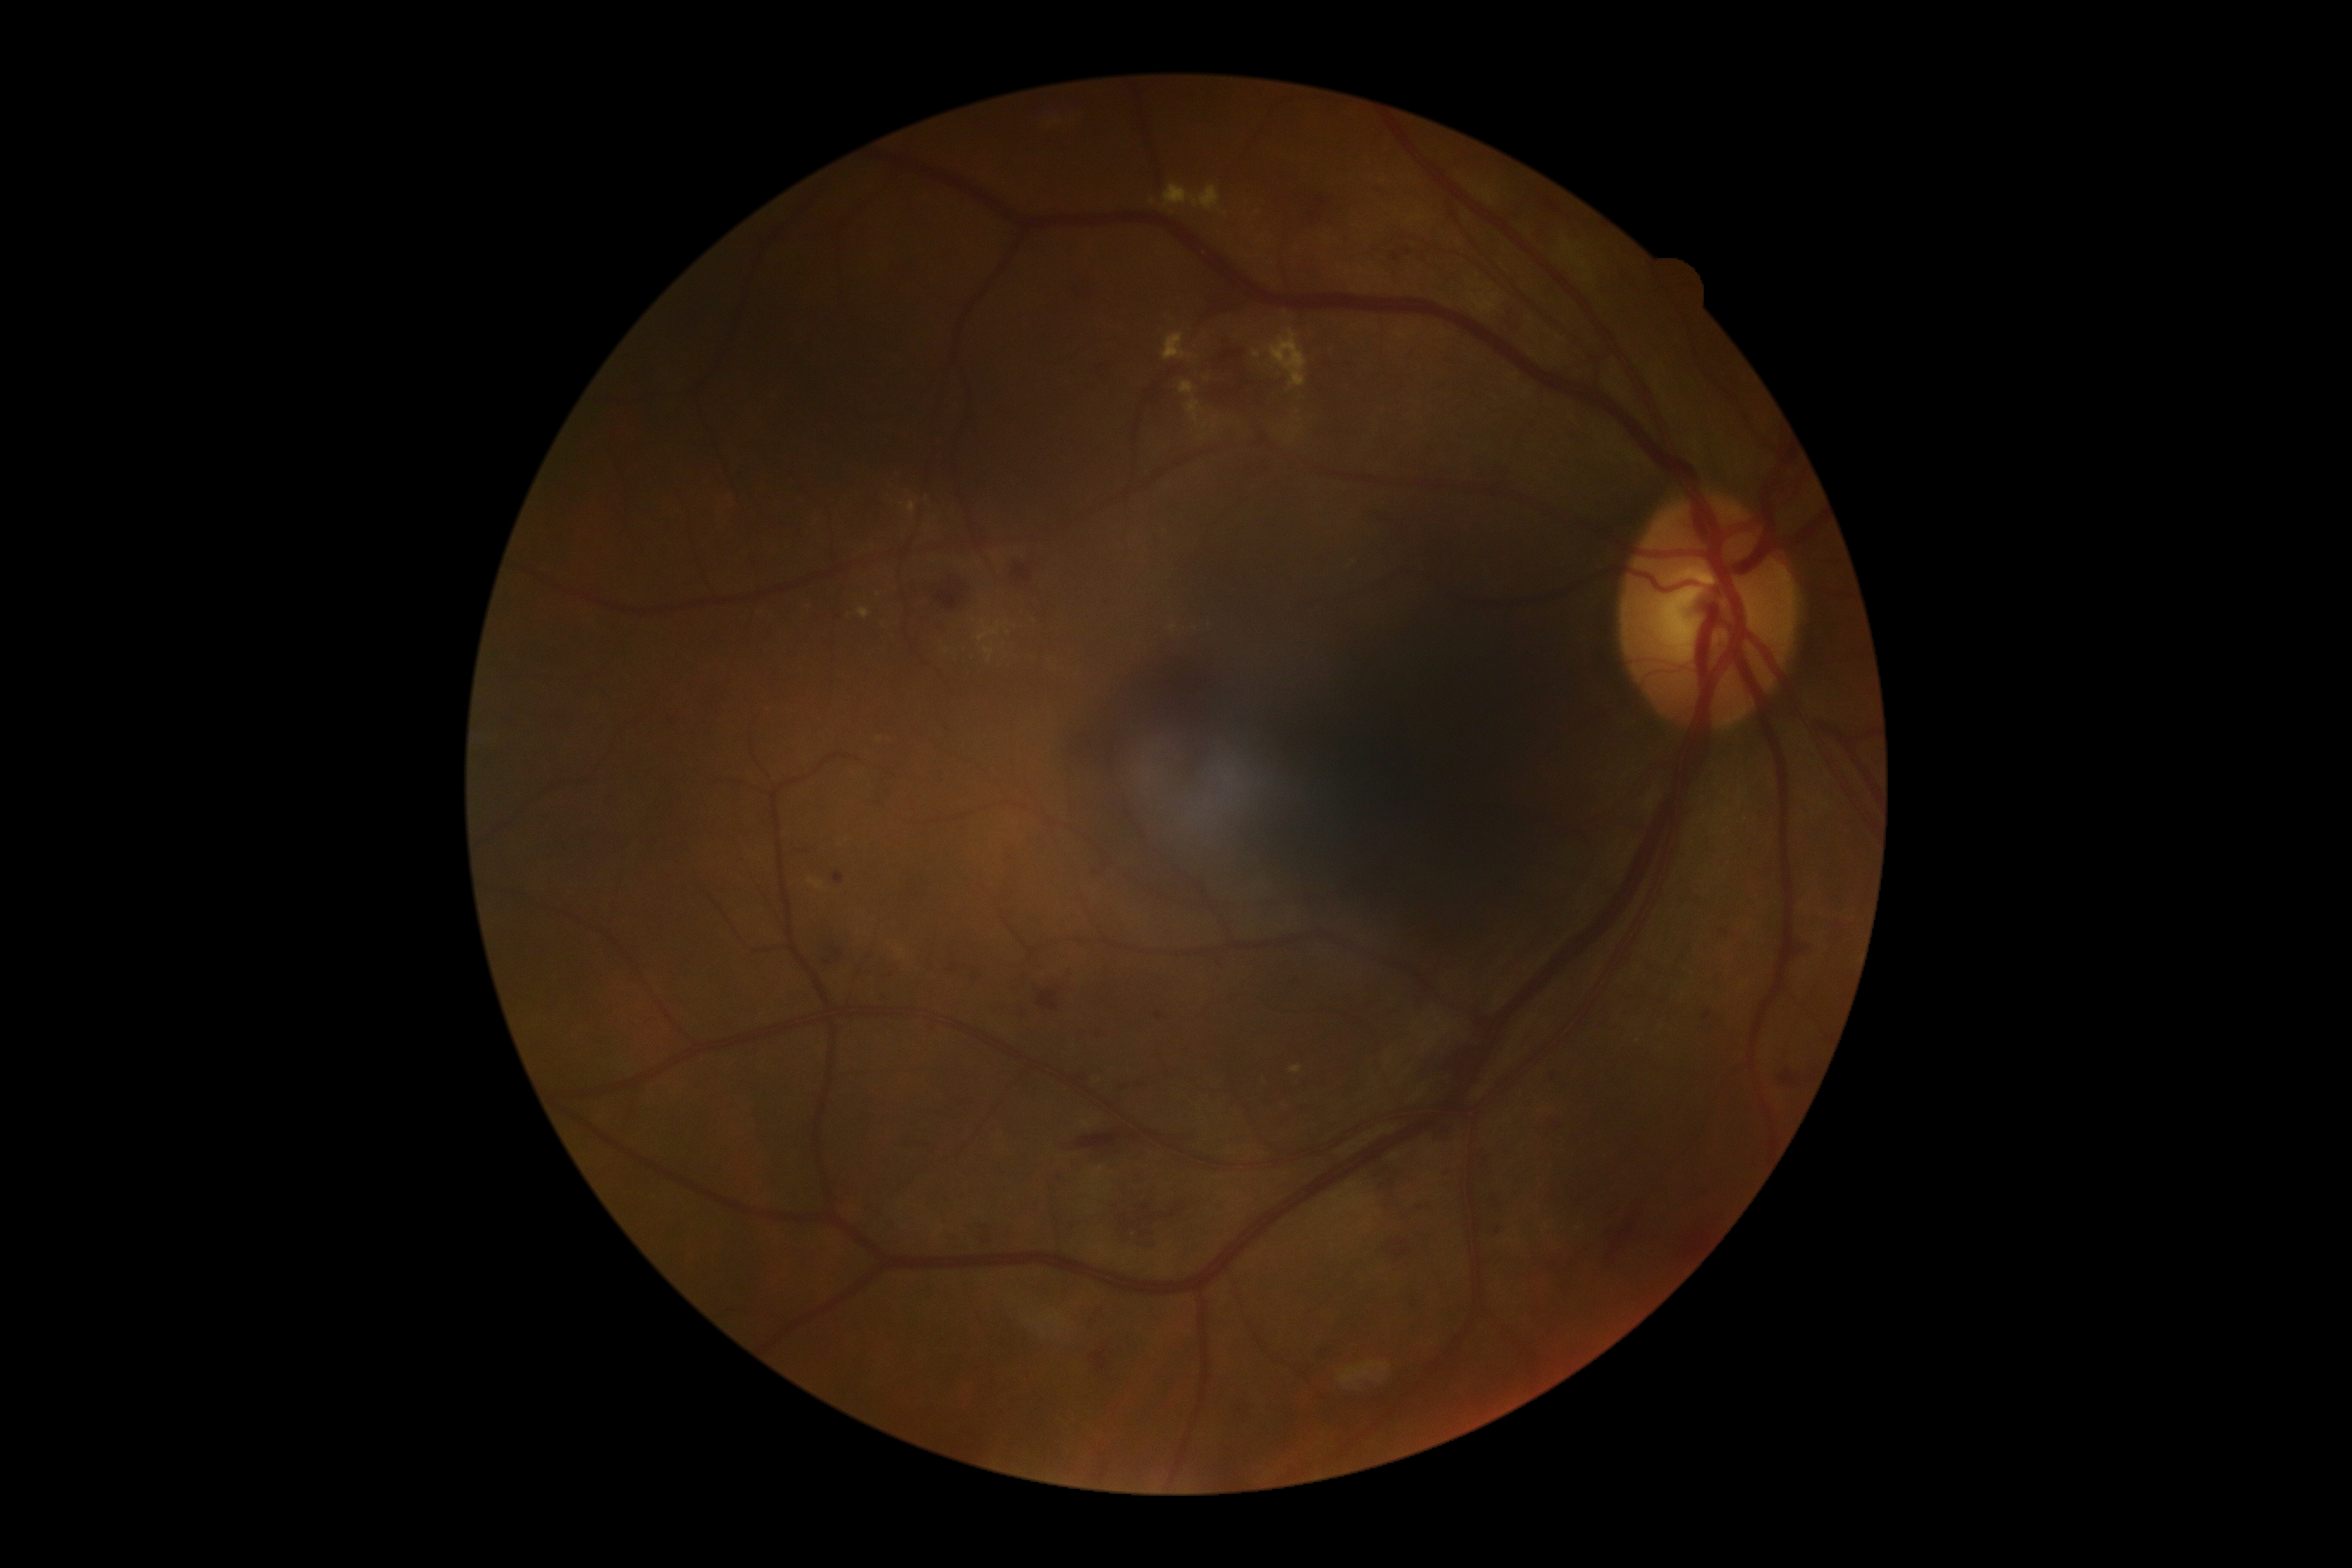
Retinopathy: 2
Representative lesions:
hemorrhages (more not shown): box=[1314, 195, 1325, 214] | box=[1368, 1161, 1409, 1191] | box=[1442, 1161, 1449, 1173] | box=[971, 1228, 988, 1246] | box=[1247, 386, 1259, 410] | box=[824, 960, 833, 965] | box=[1012, 567, 1032, 584] | box=[1385, 1234, 1416, 1256] | box=[1493, 1223, 1507, 1232] | box=[943, 721, 953, 733] | box=[965, 969, 979, 984] | box=[1409, 1297, 1419, 1313] | box=[1794, 934, 1816, 962] | box=[931, 575, 967, 611] | box=[1101, 1469, 1106, 1479] | box=[1364, 506, 1393, 522] | box=[1418, 1041, 1486, 1075] | box=[1153, 365, 1175, 405] | box=[1416, 1199, 1433, 1210]